Fundus photograph cropped around the optic nerve head.
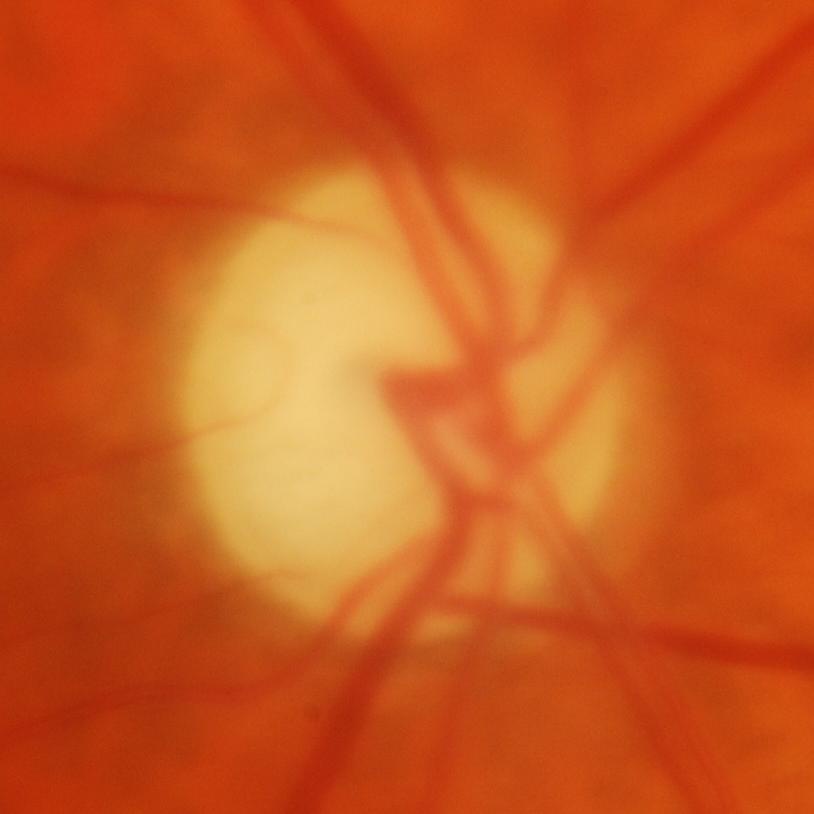
Glaucomatous optic neuropathy is present. Glaucoma status = glaucomatous changes.